FOV: 45 degrees · 2184 by 1690 pixels · CFP.
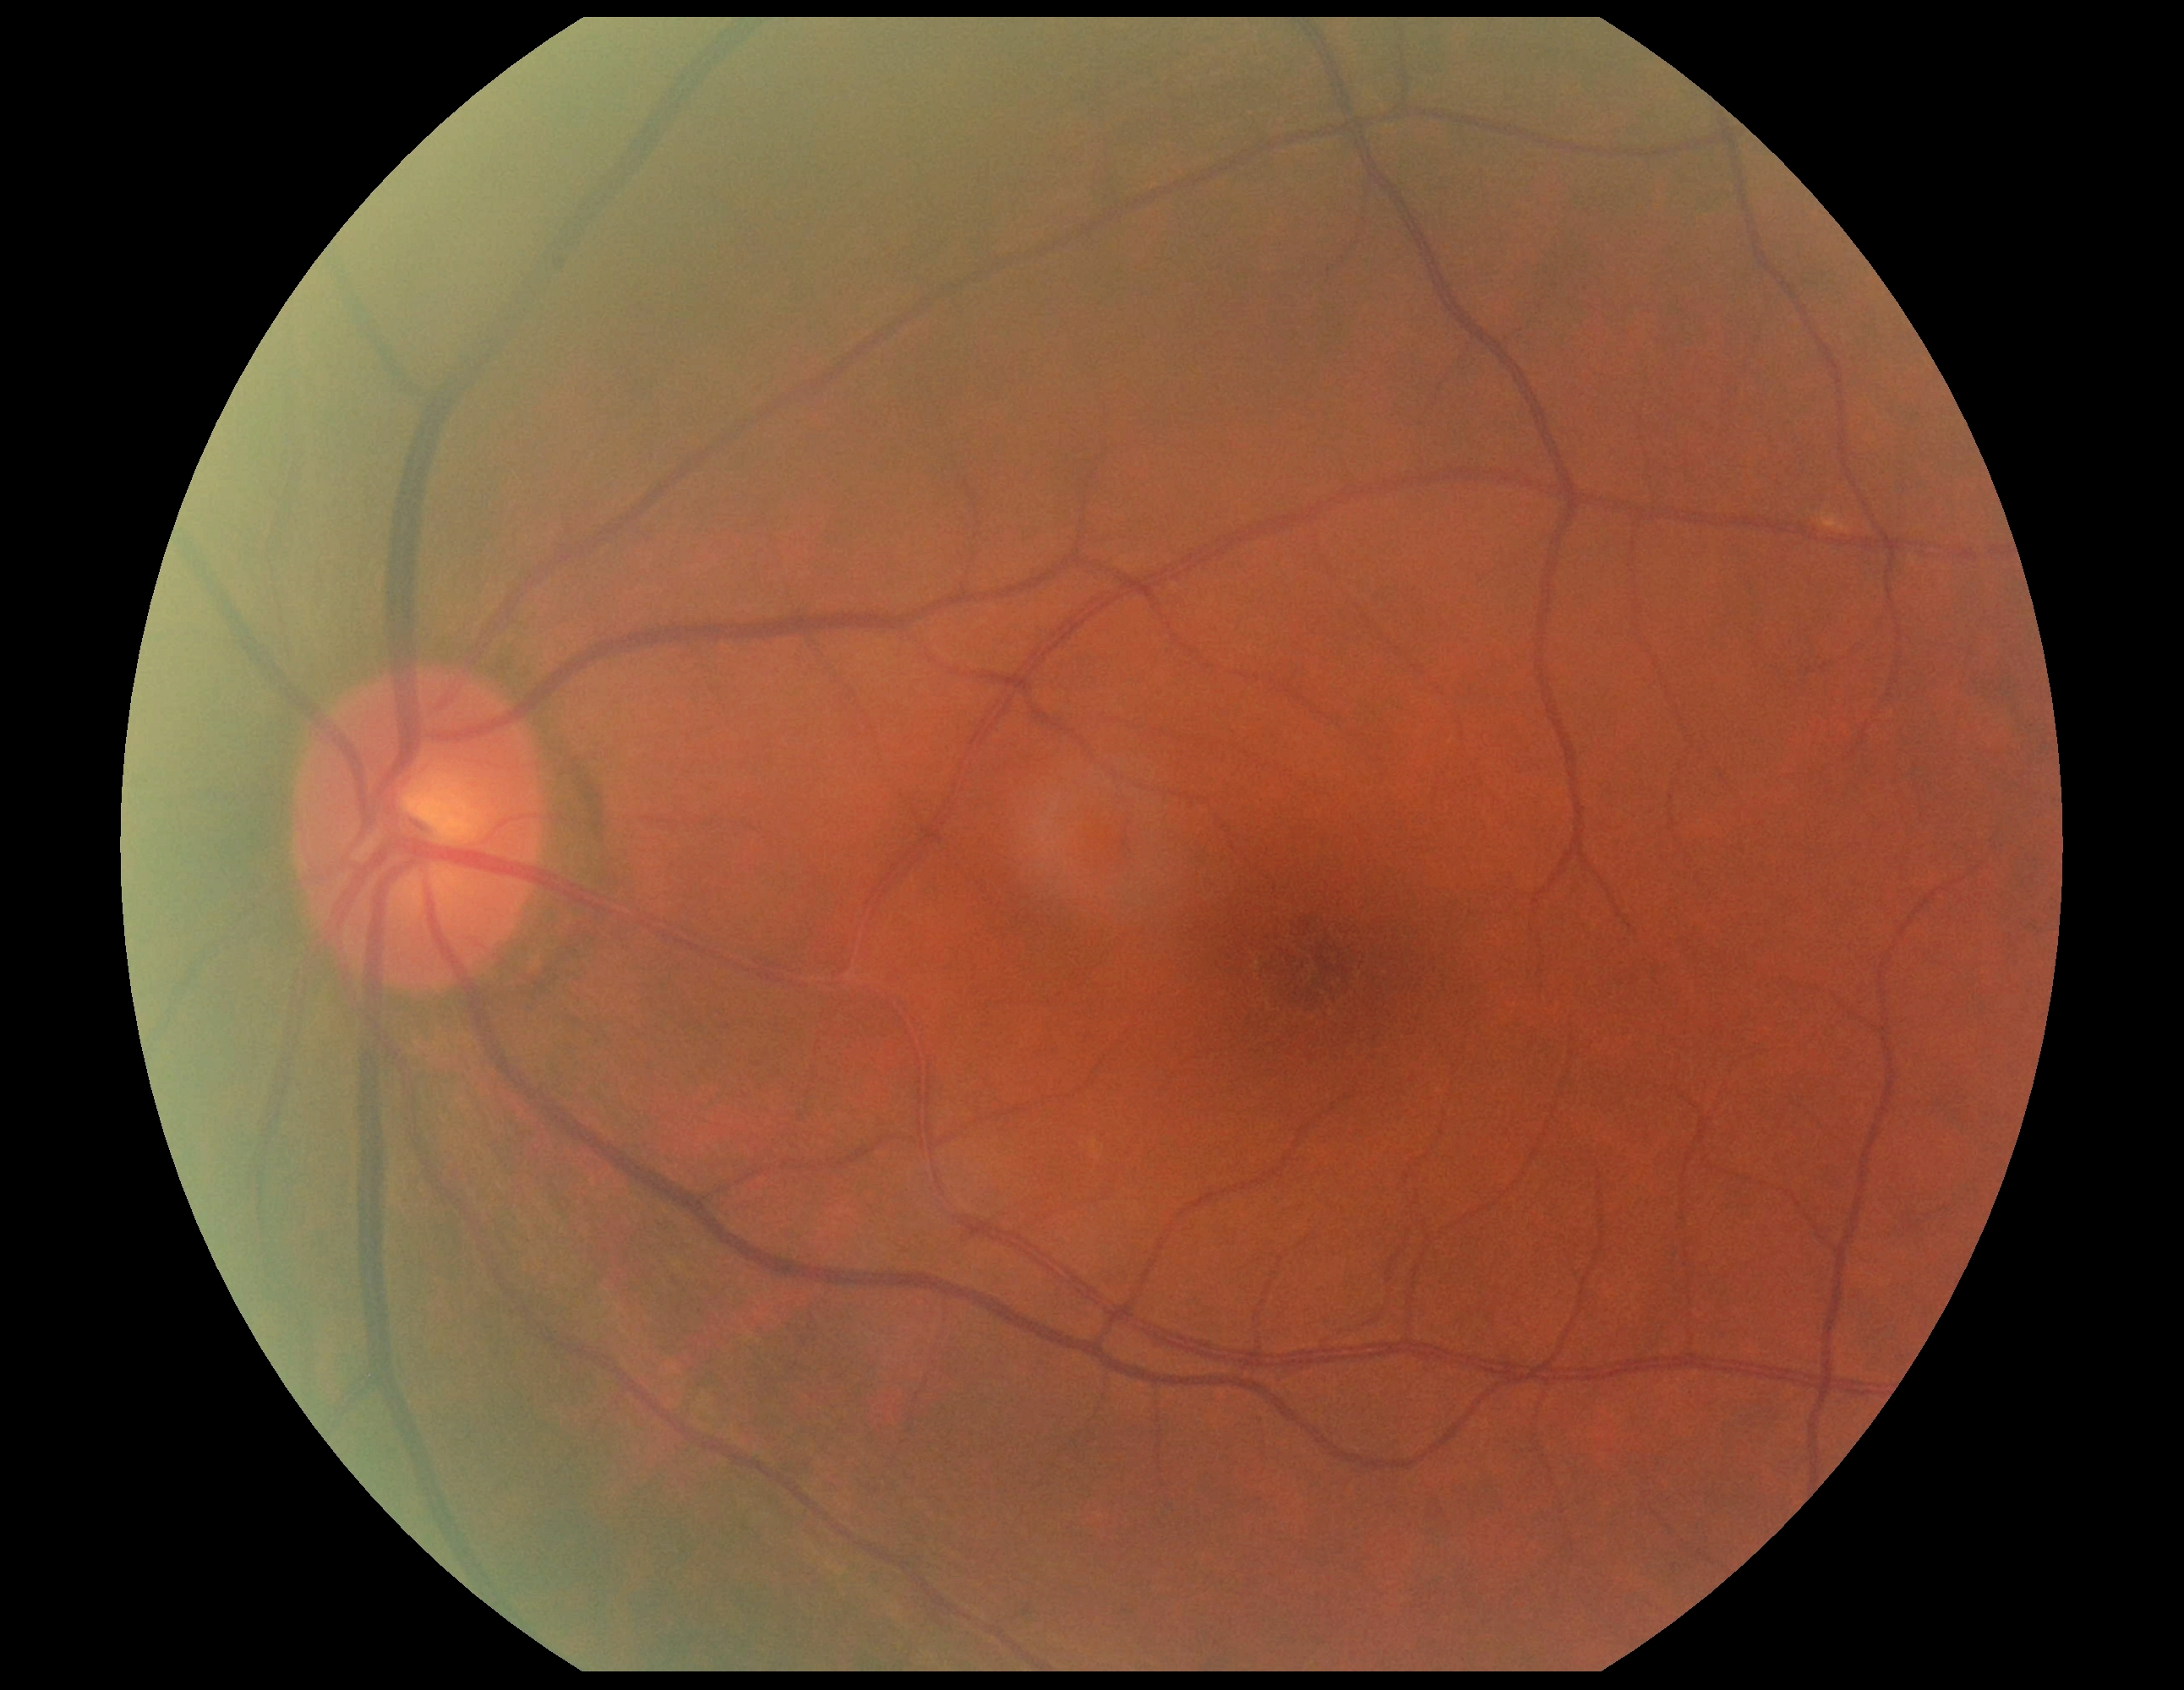
Annotations:
– DR impression: no DR findings
– diabetic retinopathy: grade 0 (no apparent retinopathy)